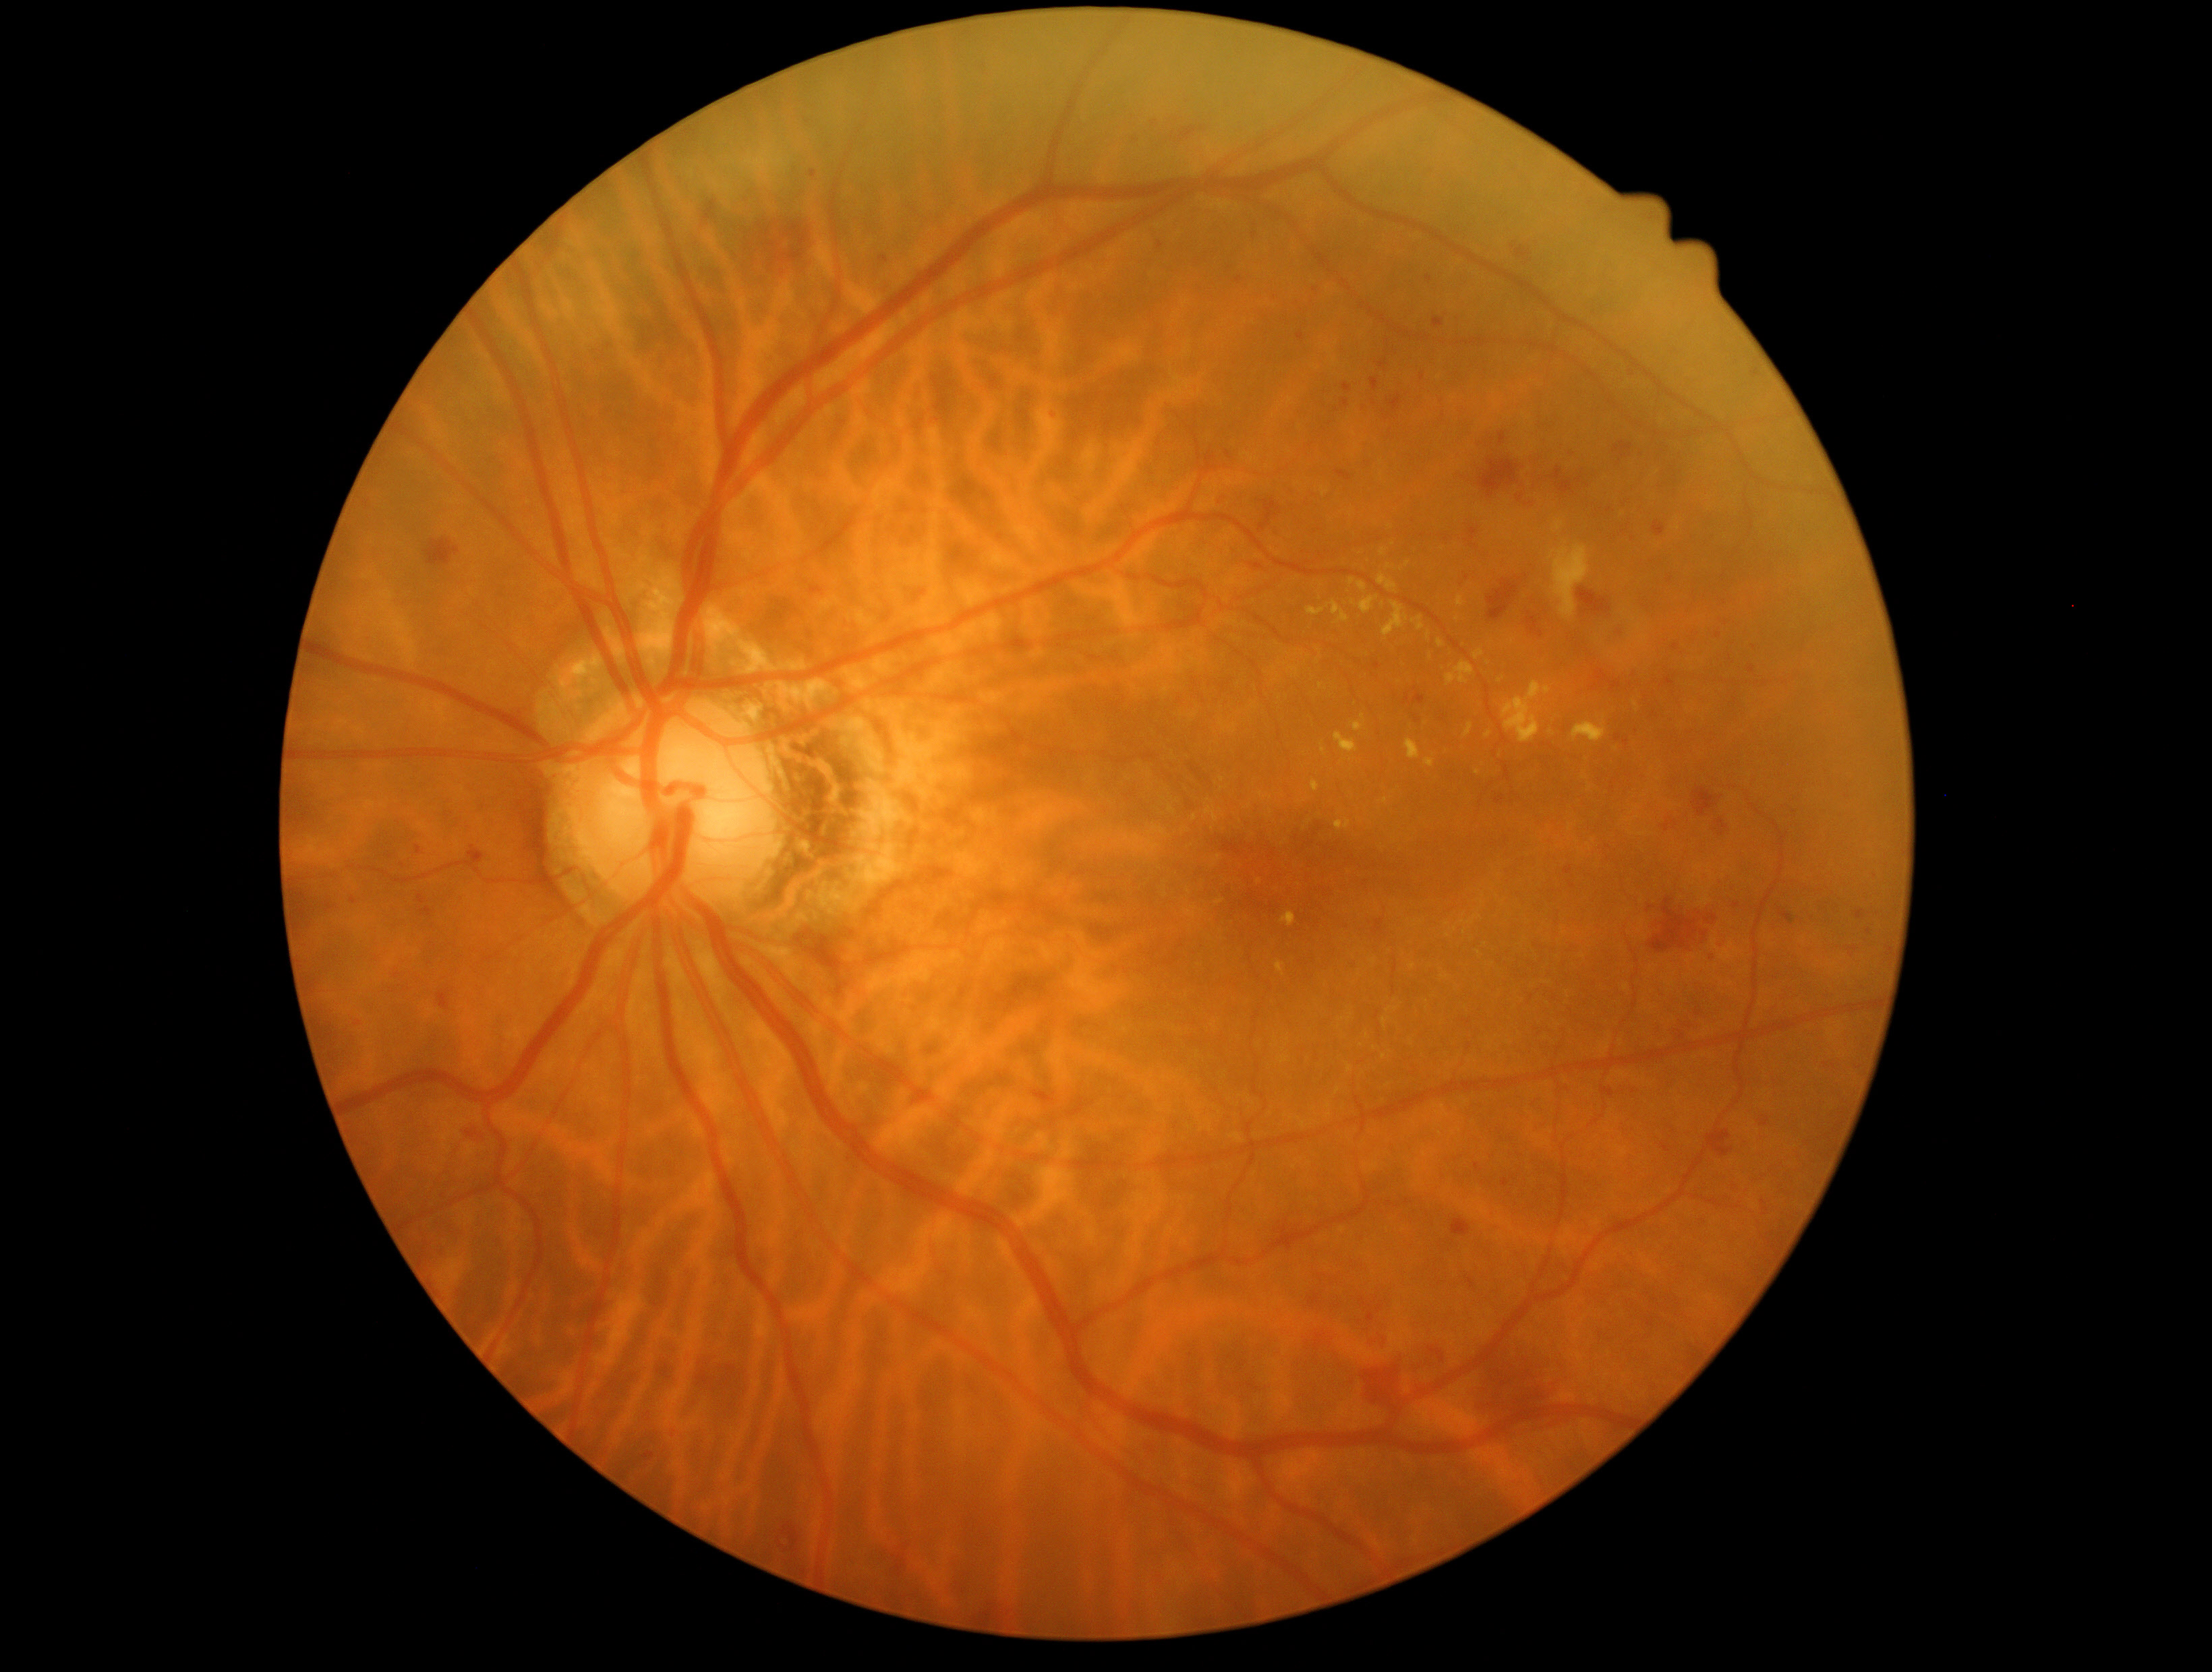 Diabetic retinopathy is 2/4
Representative lesions:
• hemorrhages (partial): {"x1": 1677, "y1": 1032, "x2": 1685, "y2": 1042}, {"x1": 1043, "y1": 409, "x2": 1062, "y2": 421}, {"x1": 1658, "y1": 810, "x2": 1681, "y2": 835}, {"x1": 416, "y1": 845, "x2": 423, "y2": 854}, {"x1": 1433, "y1": 305, "x2": 1451, "y2": 330}, {"x1": 1269, "y1": 292, "x2": 1282, "y2": 305}, {"x1": 1600, "y1": 1086, "x2": 1614, "y2": 1098}, {"x1": 1855, "y1": 1066, "x2": 1863, "y2": 1071}, {"x1": 1527, "y1": 617, "x2": 1544, "y2": 638}, {"x1": 1294, "y1": 408, "x2": 1313, "y2": 423}, {"x1": 694, "y1": 1356, "x2": 747, "y2": 1396}, {"x1": 1348, "y1": 961, "x2": 1358, "y2": 972}, {"x1": 1337, "y1": 335, "x2": 1364, "y2": 366}, {"x1": 1340, "y1": 922, "x2": 1349, "y2": 931}
• Small hemorrhages near [1767,1210], [1308,1345], [1573,886], [353,900]